Infant wide-field retinal image; 130° field of view (Natus RetCam Envision) — 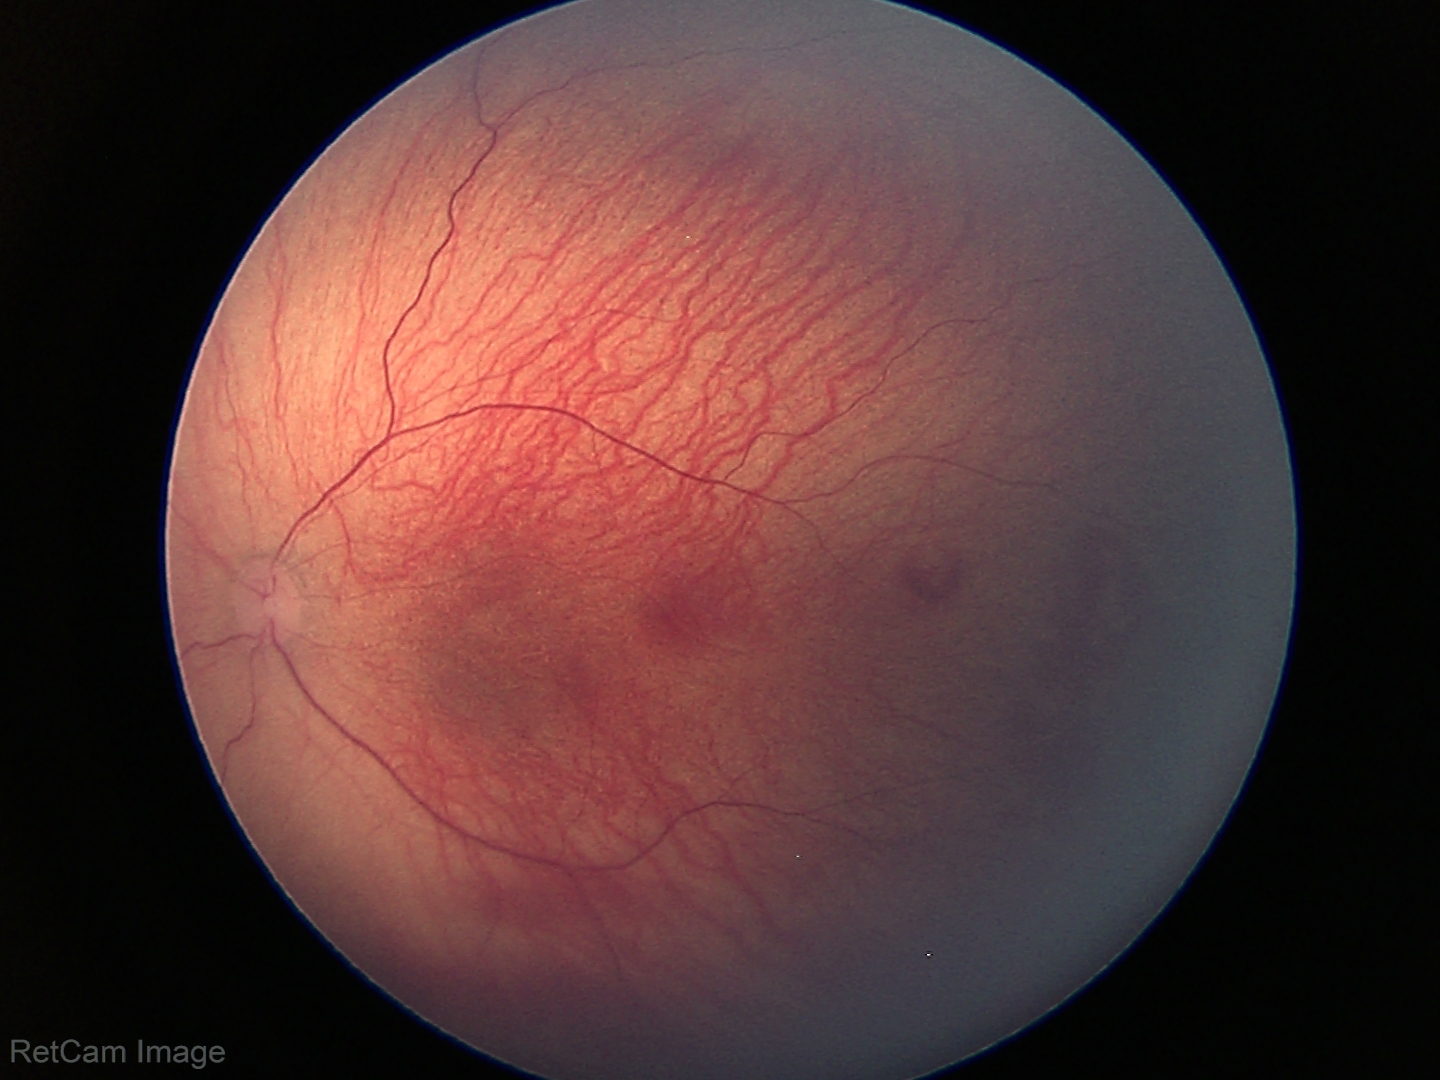

From an examination with diagnosis of ROP stage 1. Plus disease absent.